1960 x 1897 pixels
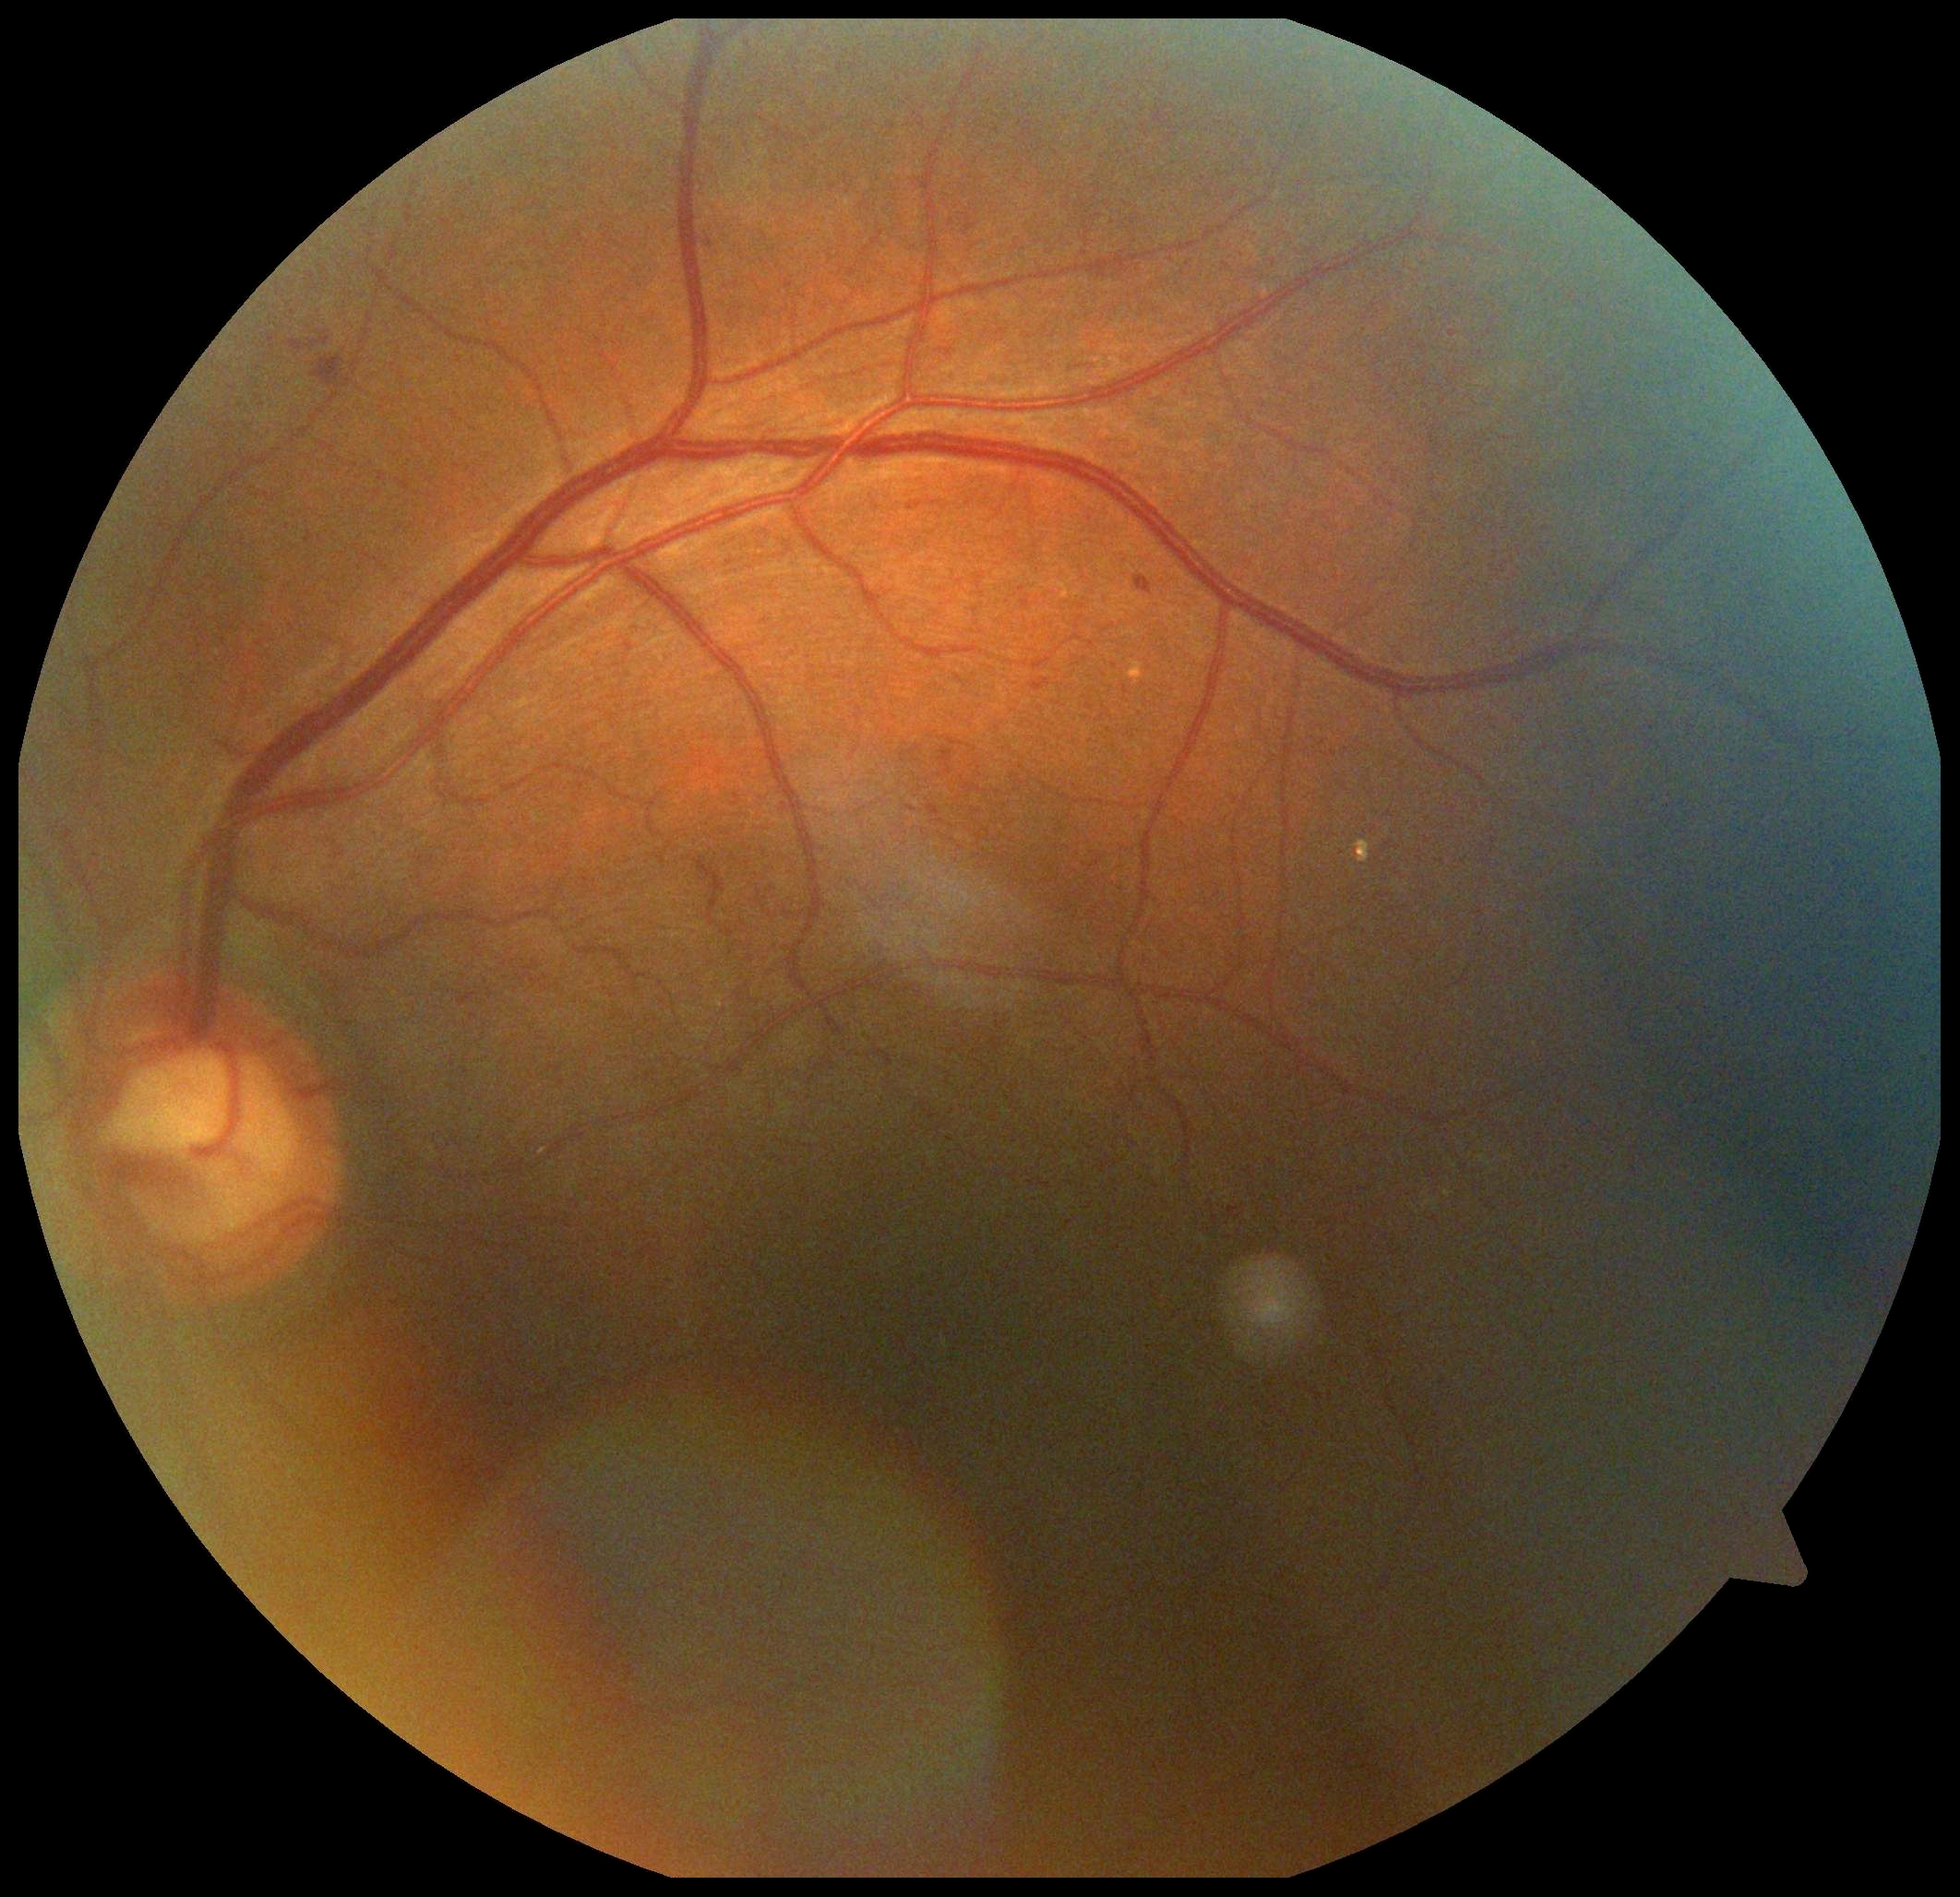 Diabetic retinopathy (DR): grade 2.